45-degree field of view · CFP: 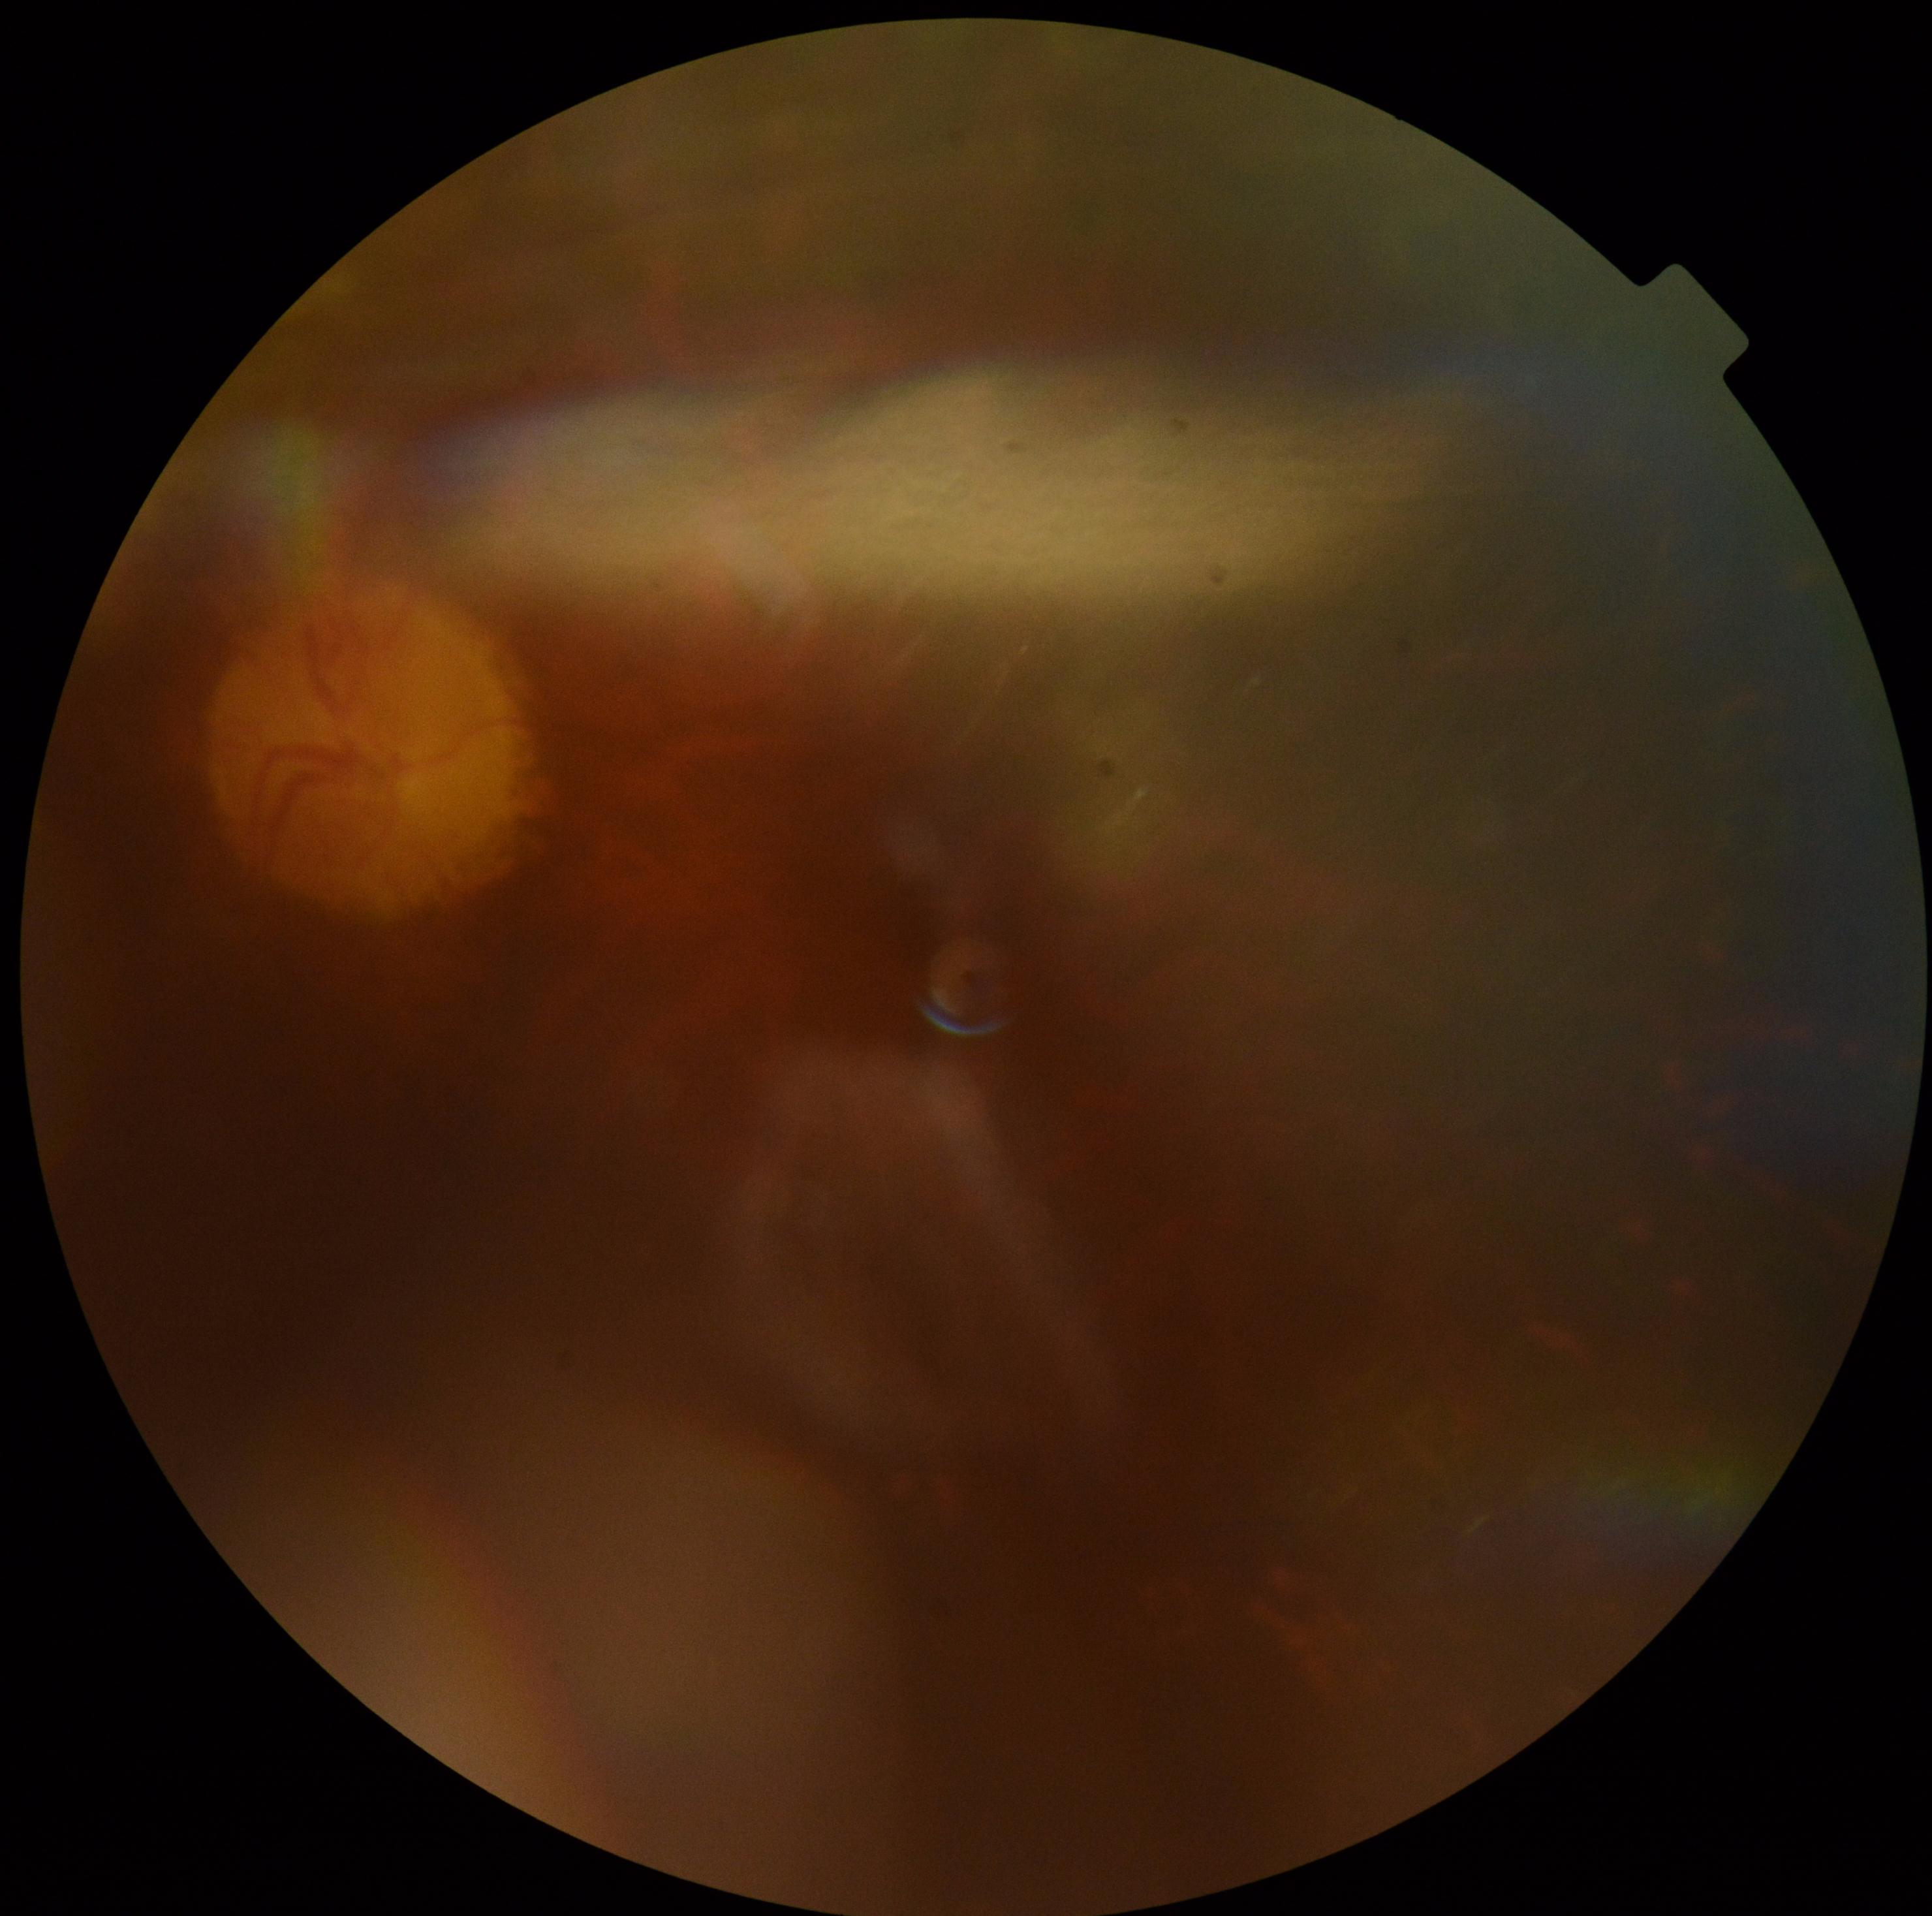   quality: too poor for DR grading
  dr_grade: ungradable due to poor image quality